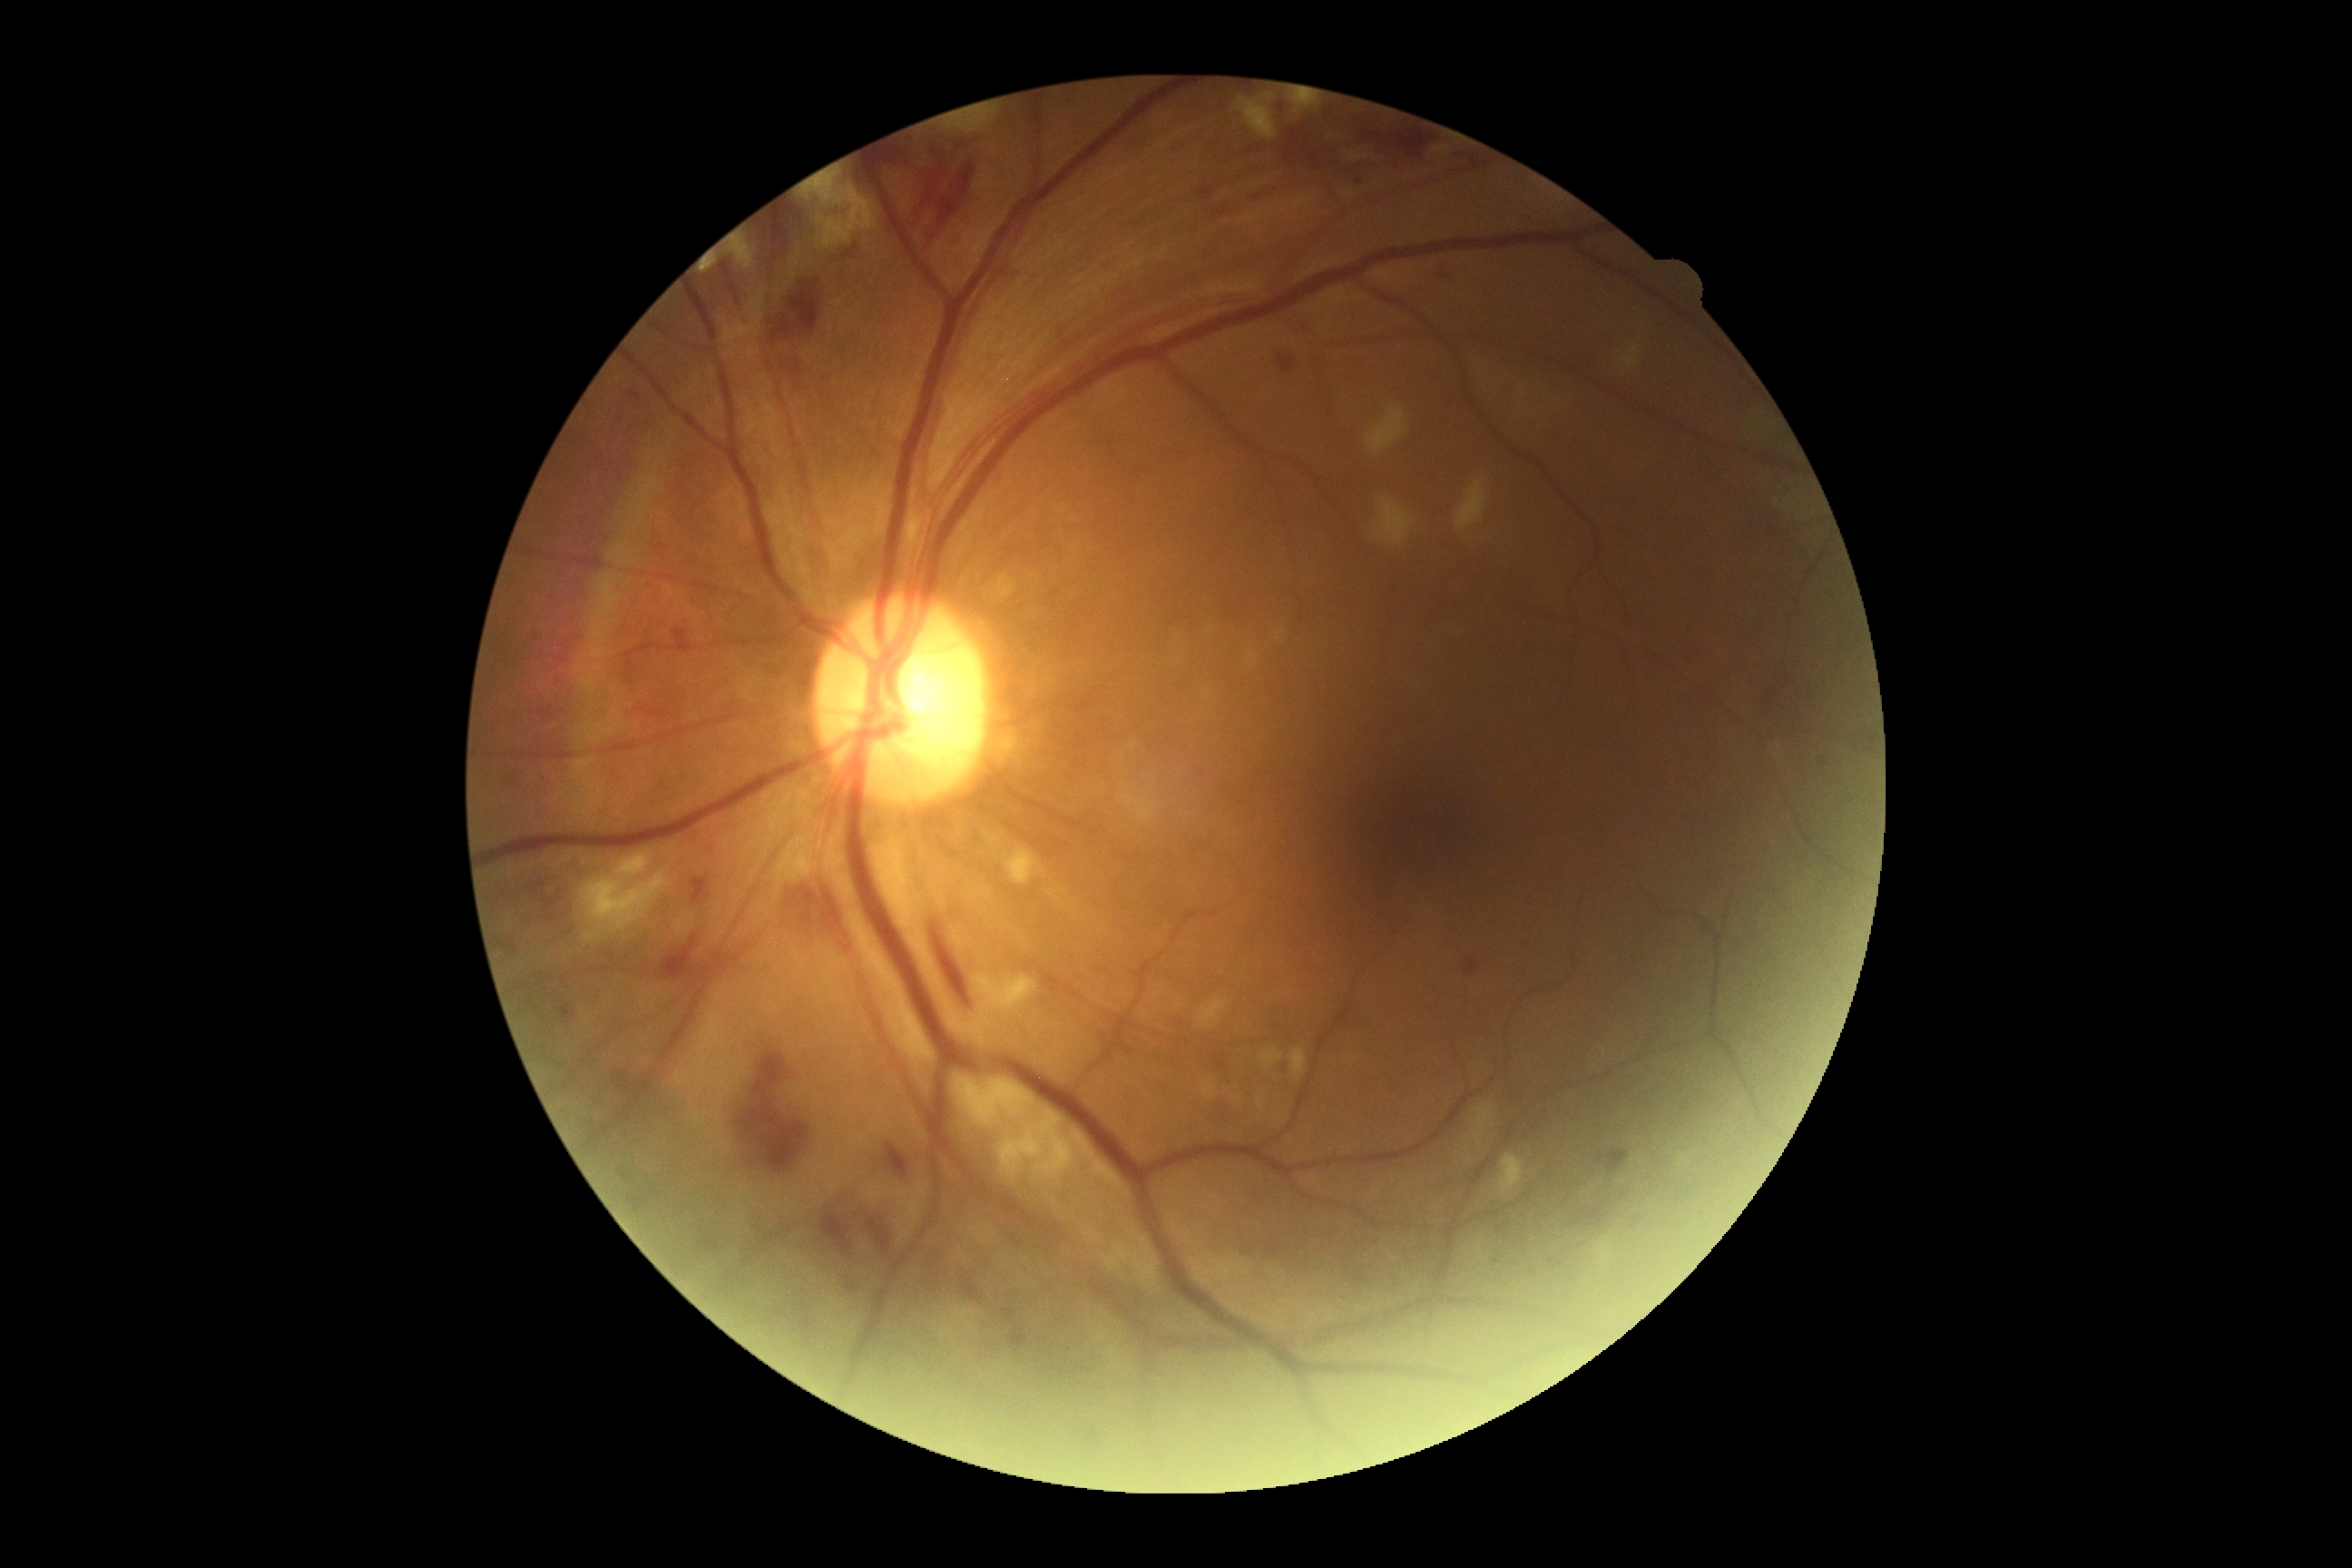

Diabetic retinopathy grade: 2.